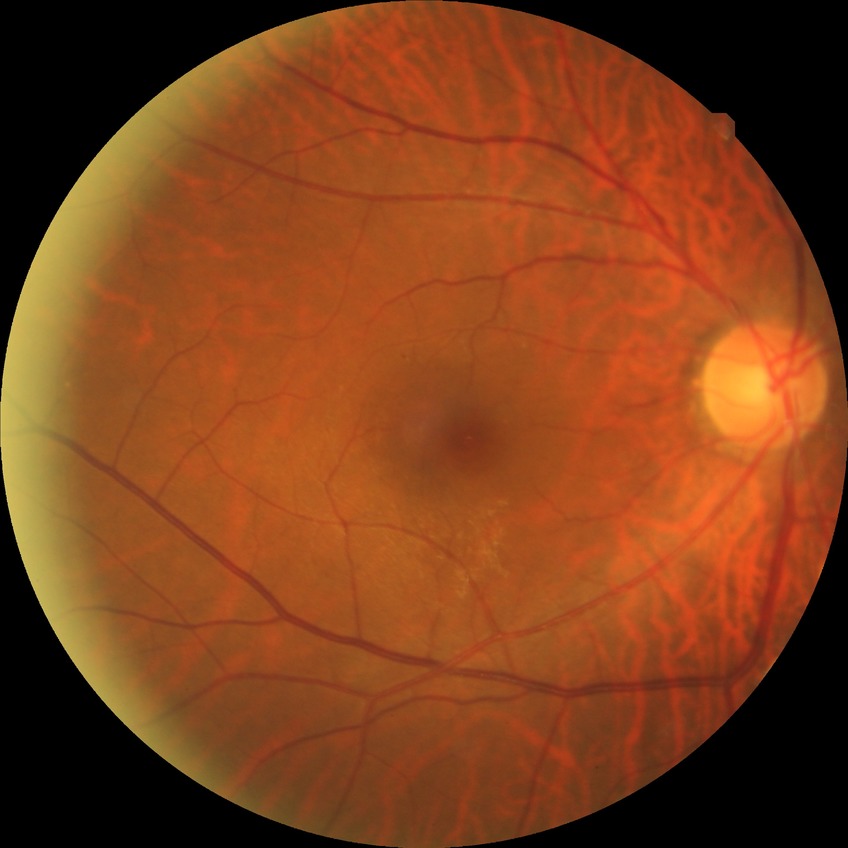

Findings:
• DR impression: negative for DR
• DR stage: NDR